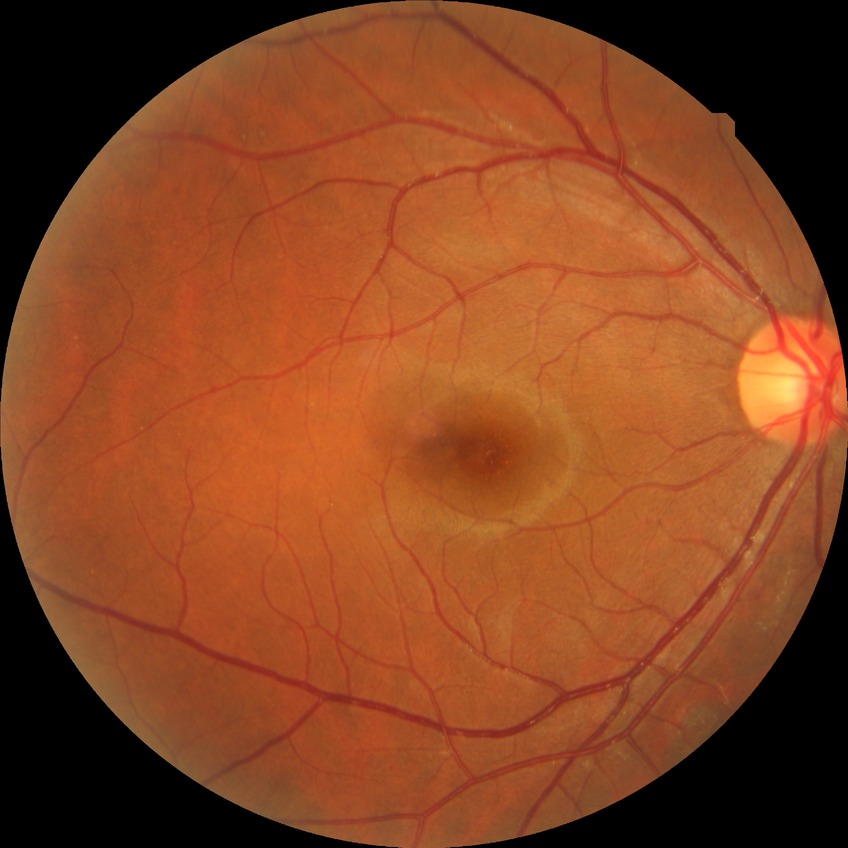 diabetic retinopathy (DR): NDR (no diabetic retinopathy).